CFP: 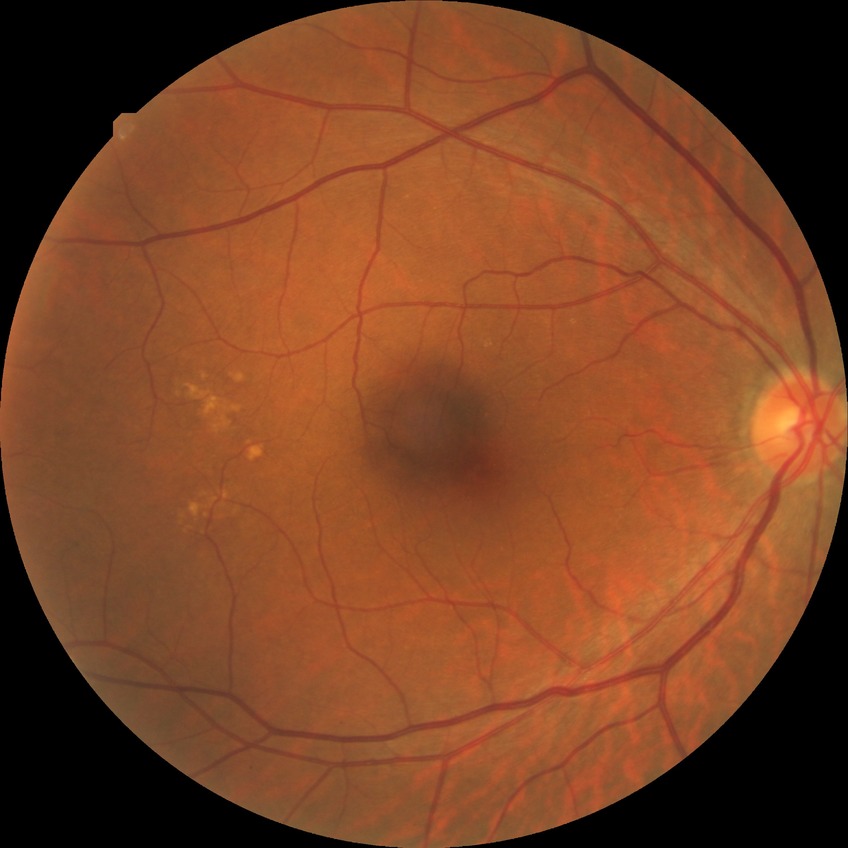 {"davis_grade": "NDR"}